NIDEK AFC-230 fundus camera · diabetic retinopathy graded by the modified Davis classification.
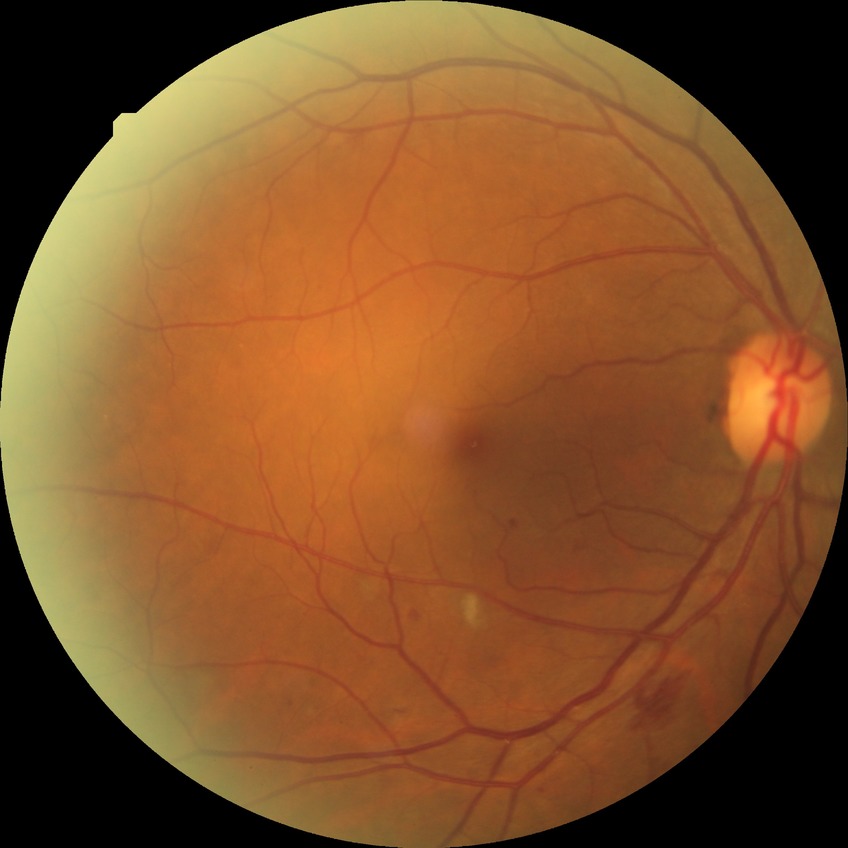
Diabetic retinopathy (DR) is PPDR (pre-proliferative diabetic retinopathy).